Non-mydriatic
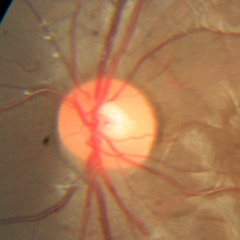
Fundus appearance consistent with no glaucomatous changes.